Fundus photograph cropped around the optic nerve head.
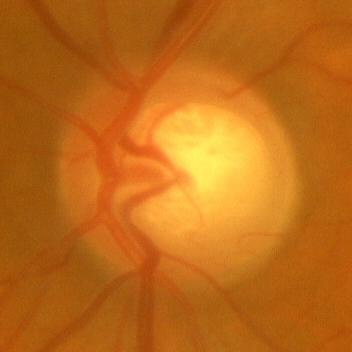 Demonstrates no glaucomatous changes.